45° FOV, color fundus photograph, 2212x1659 — 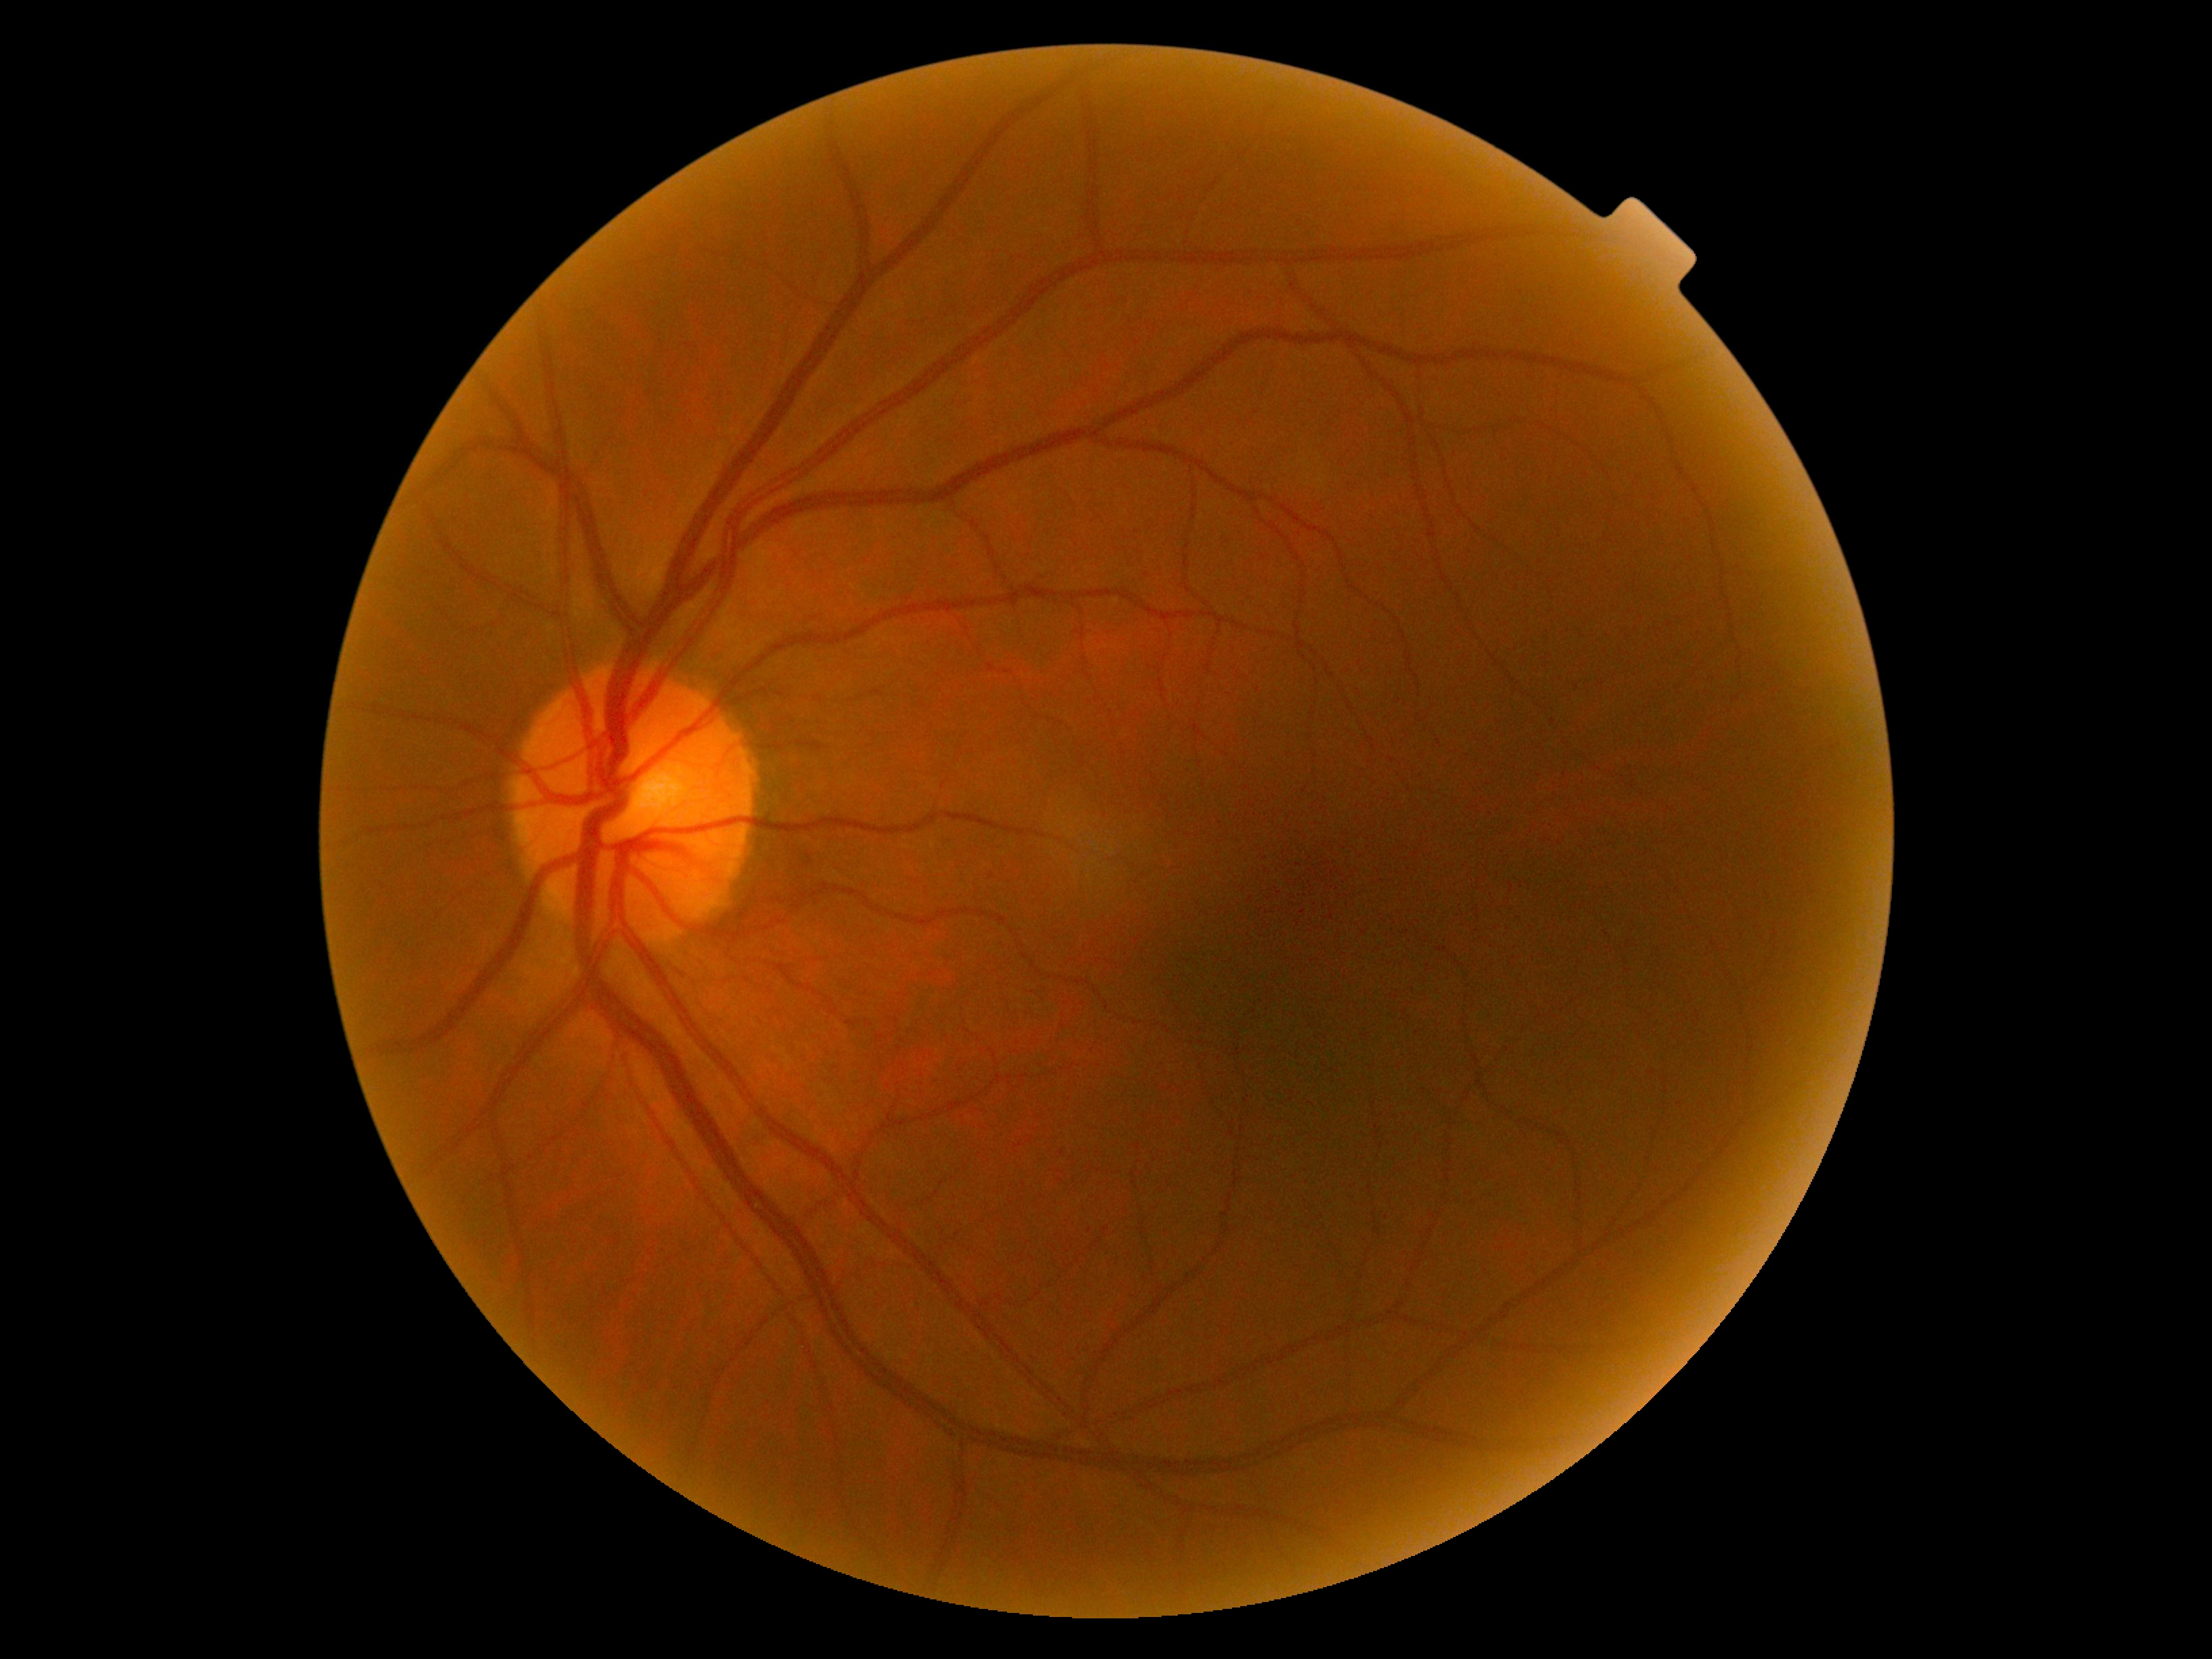
DR grade is no apparent diabetic retinopathy (0).